100° field of view (Phoenix ICON). Wide-field fundus photograph from neonatal ROP screening.
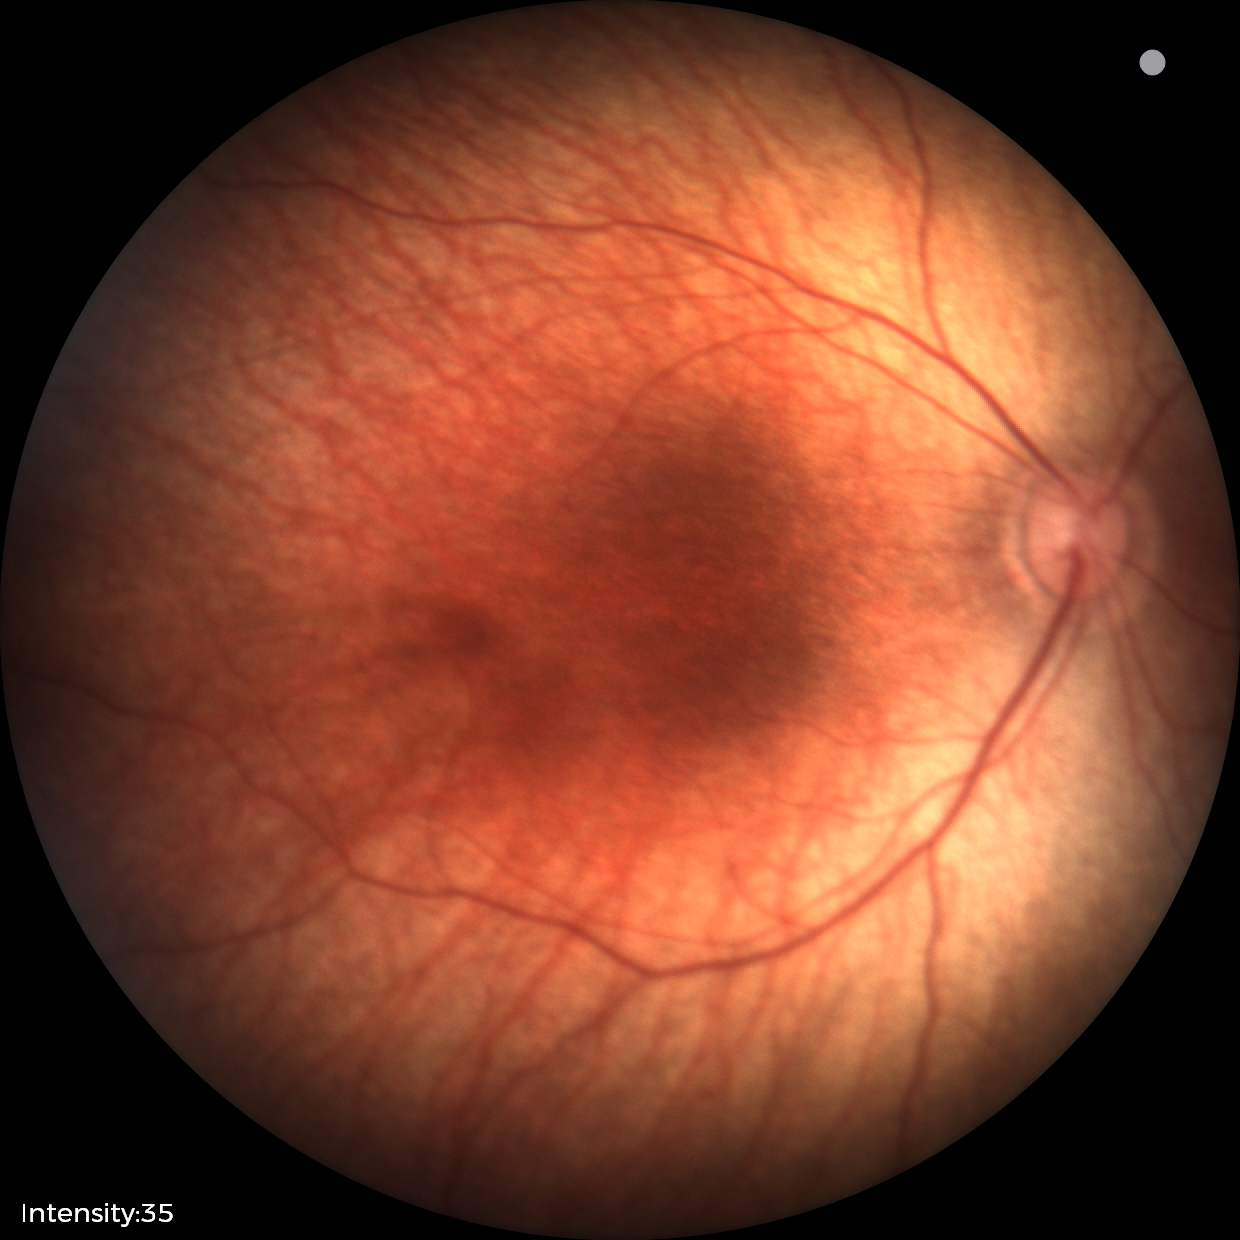

Screening examination diagnosed as physiological.